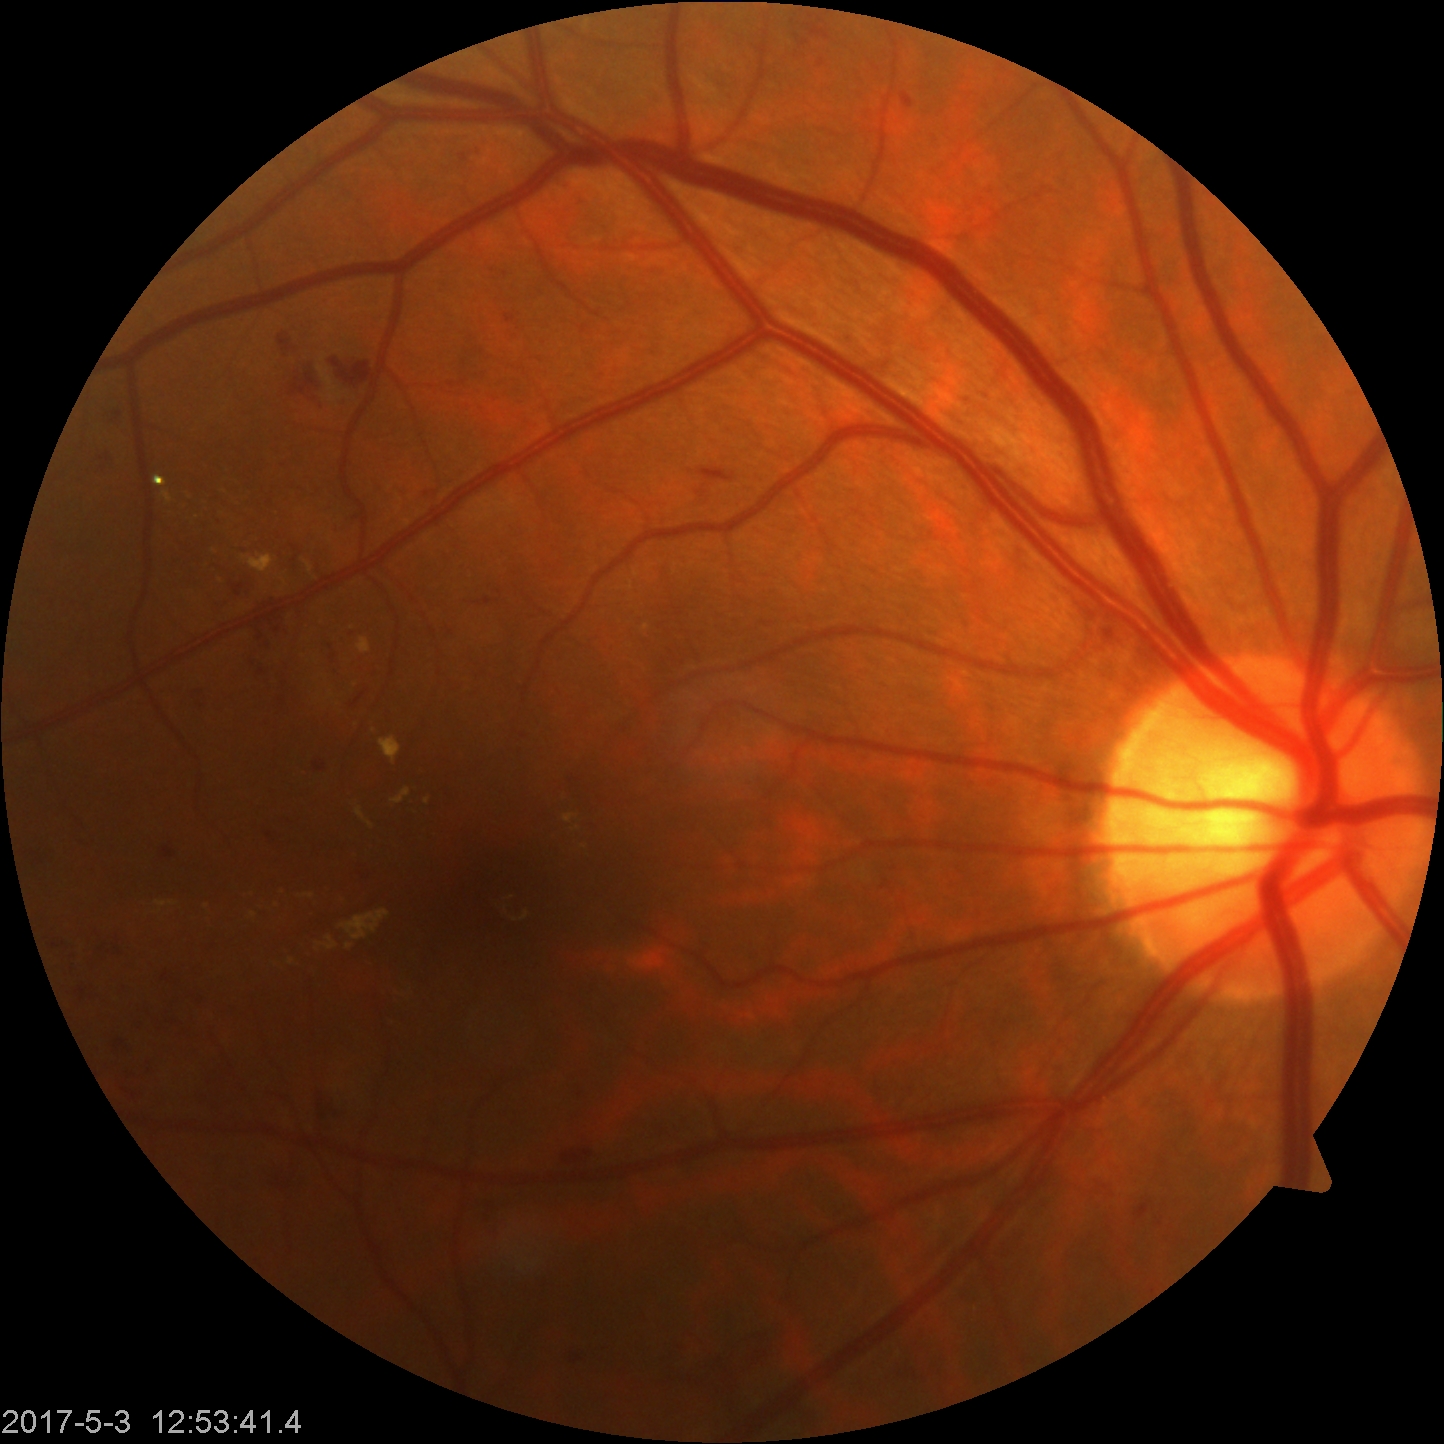
Retinal fundus photograph demonstrating moderate non-proliferative diabetic retinopathy.